Infant wide-field retinal image.
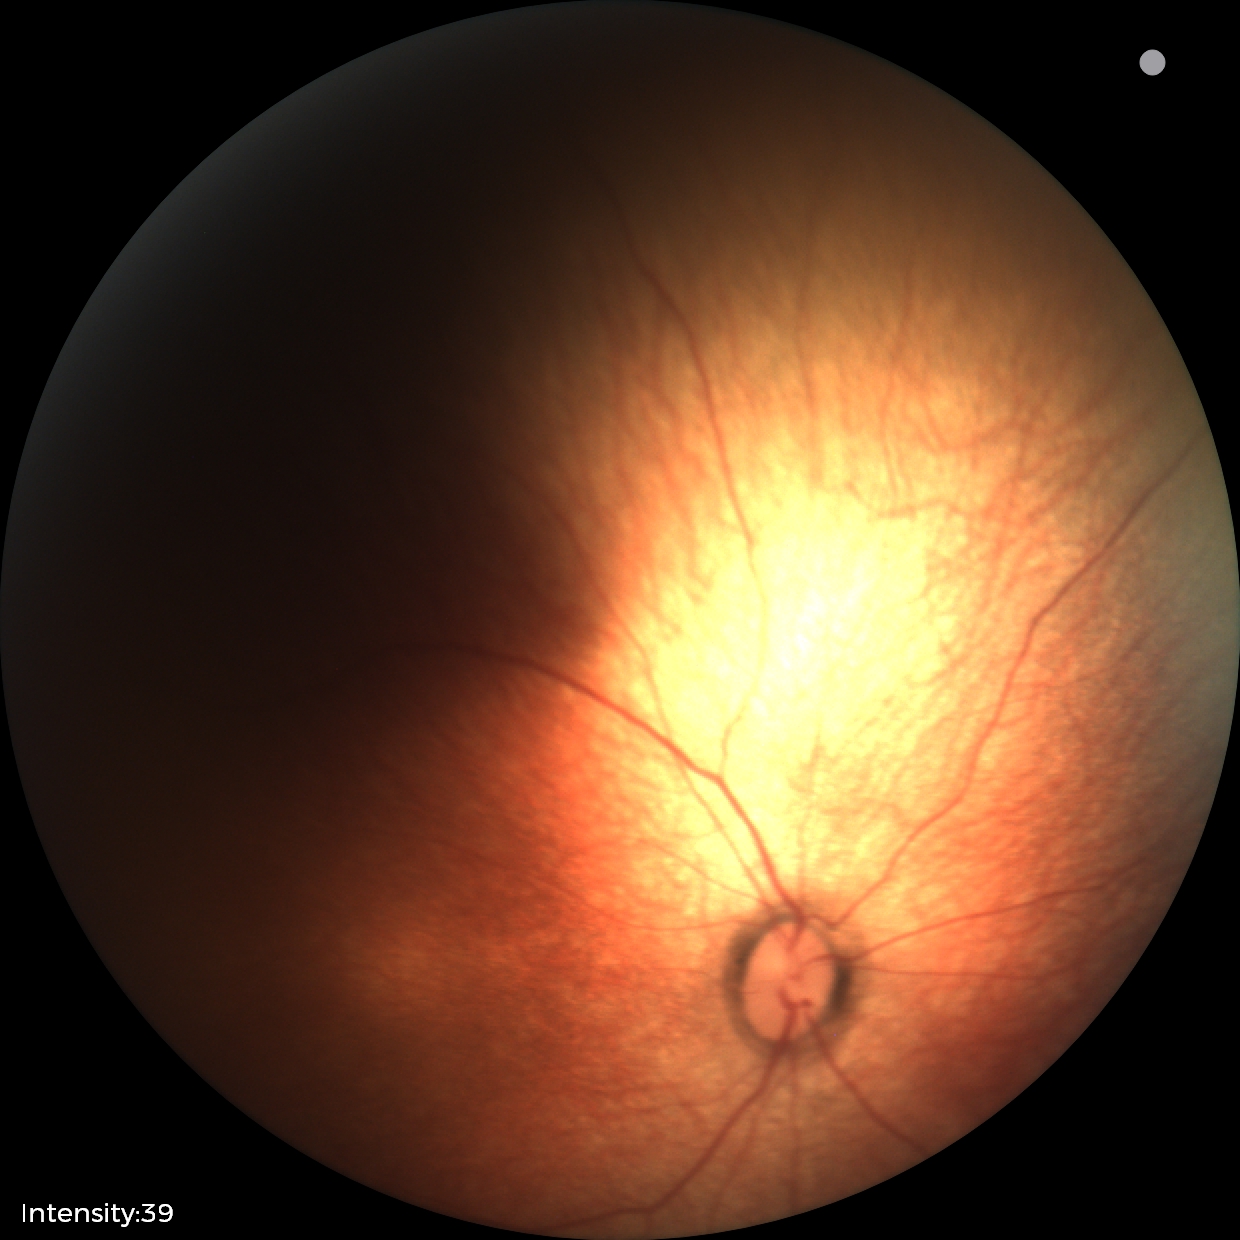

Screening diagnosis: no abnormalities.